50° field of view · color fundus image: 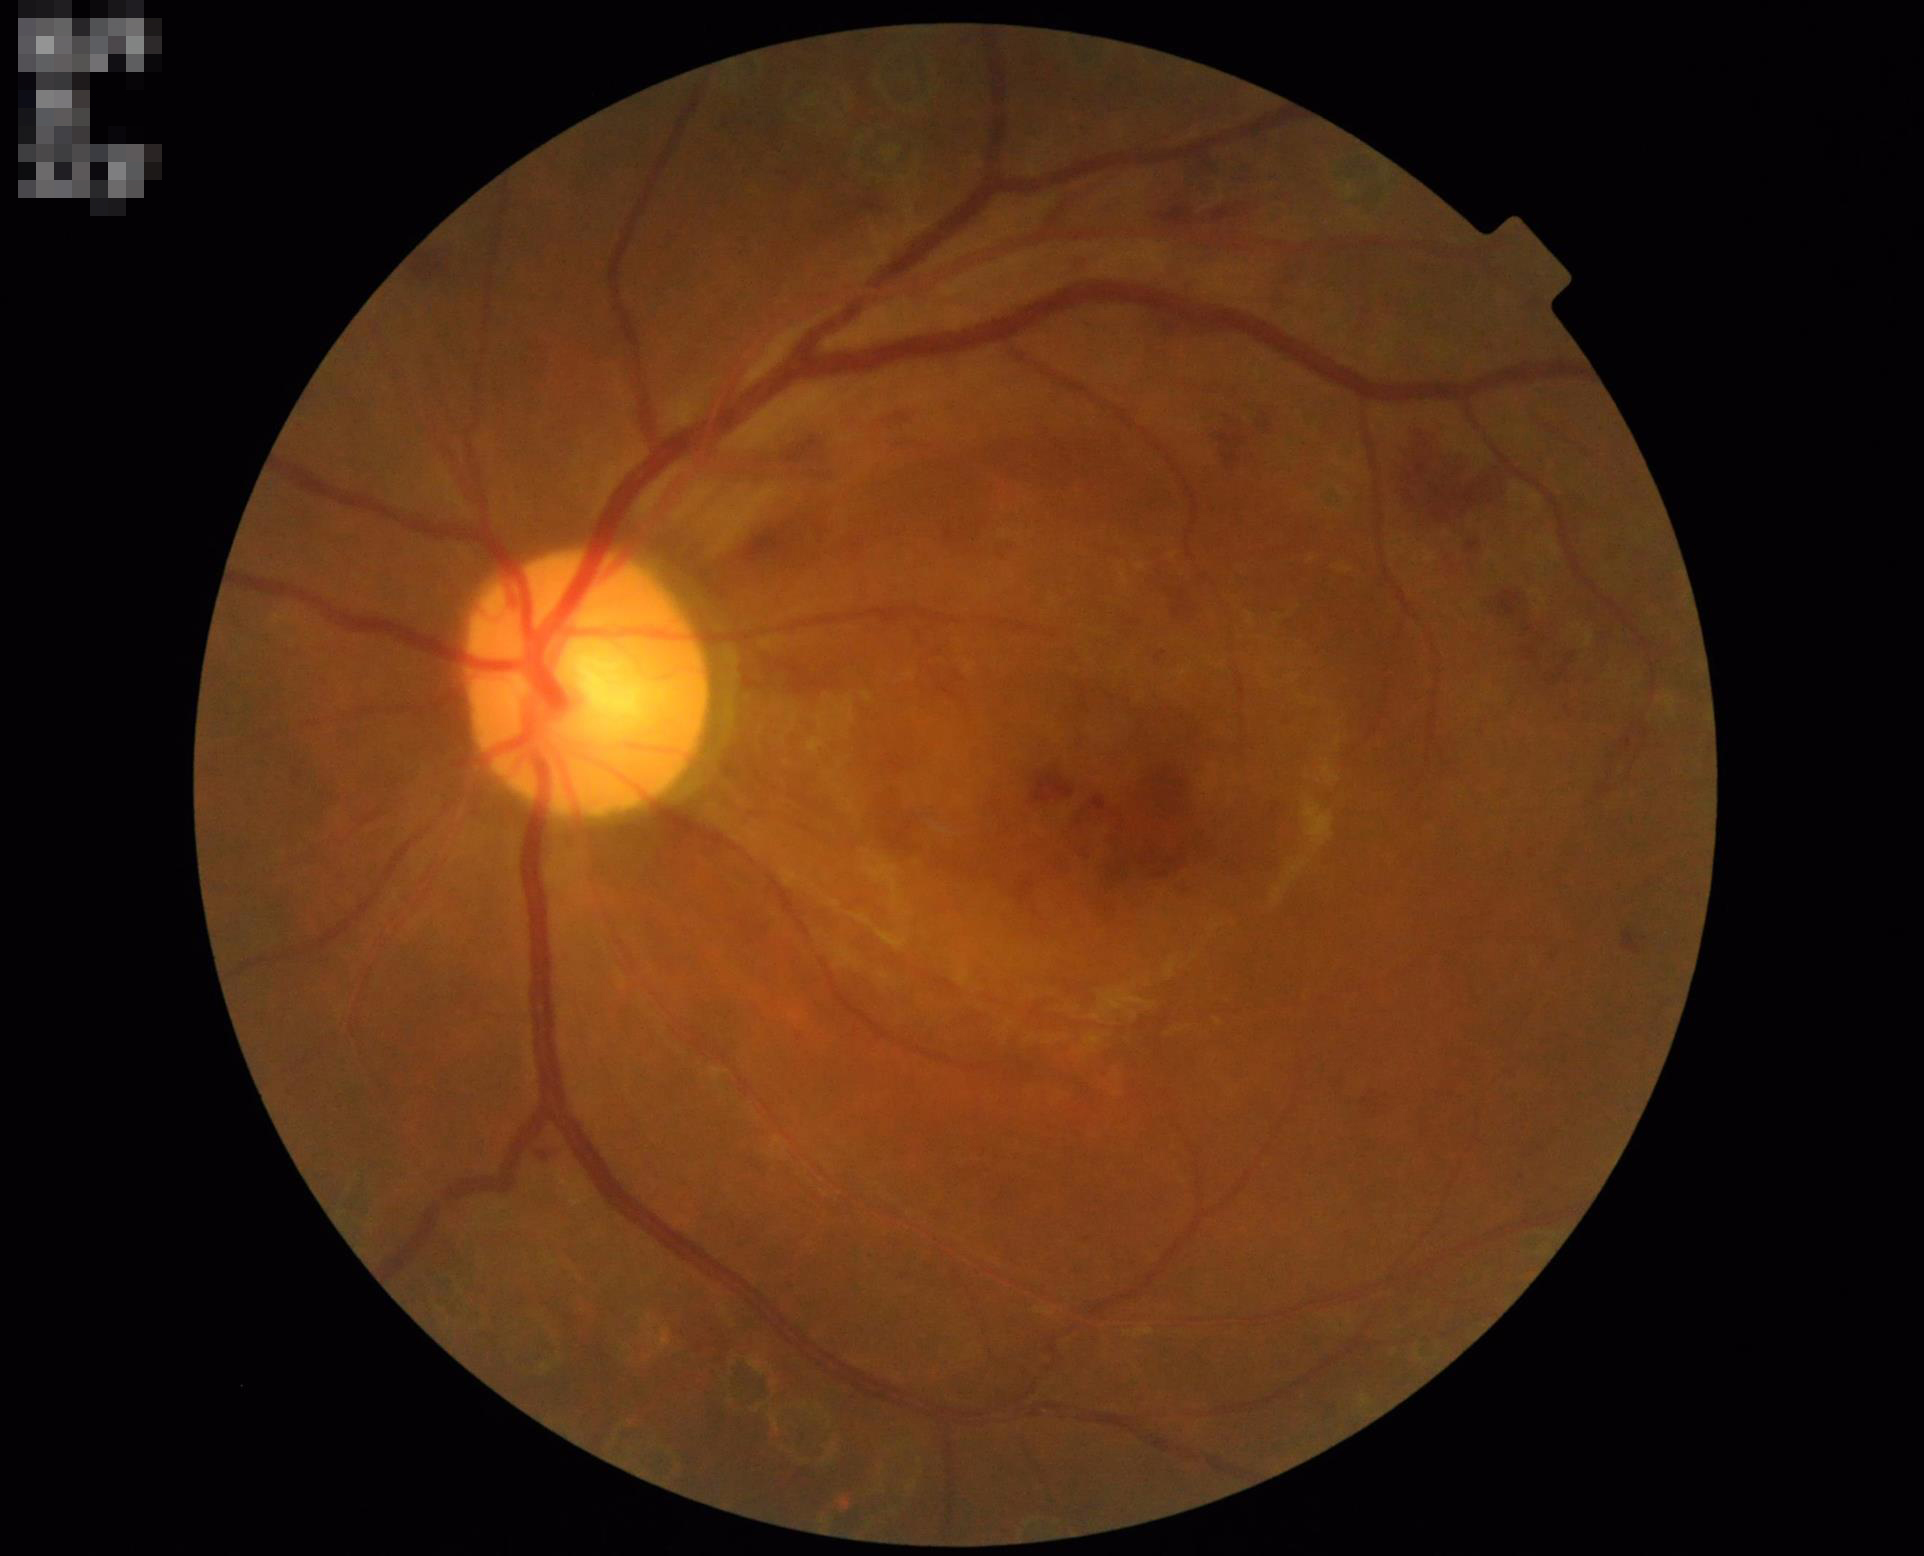
Contrast is good. Image is sharp throughout the field. Overall quality is good and the image is gradable.